Acquired on the Clarity RetCam 3. Wide-field fundus photograph from neonatal ROP screening
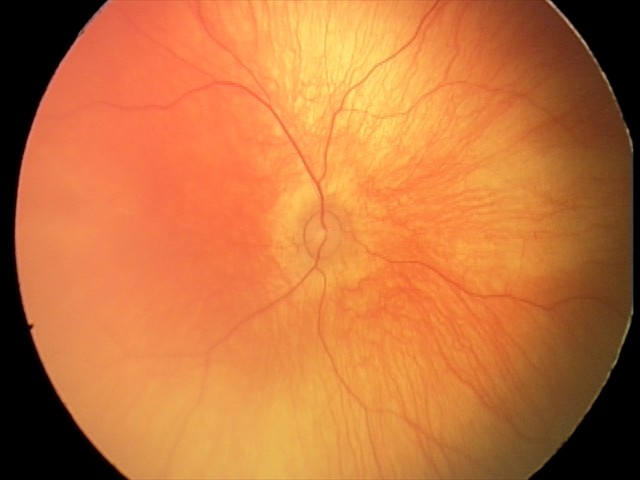
Screening examination with no abnormal retinal findings.